2352x1568.
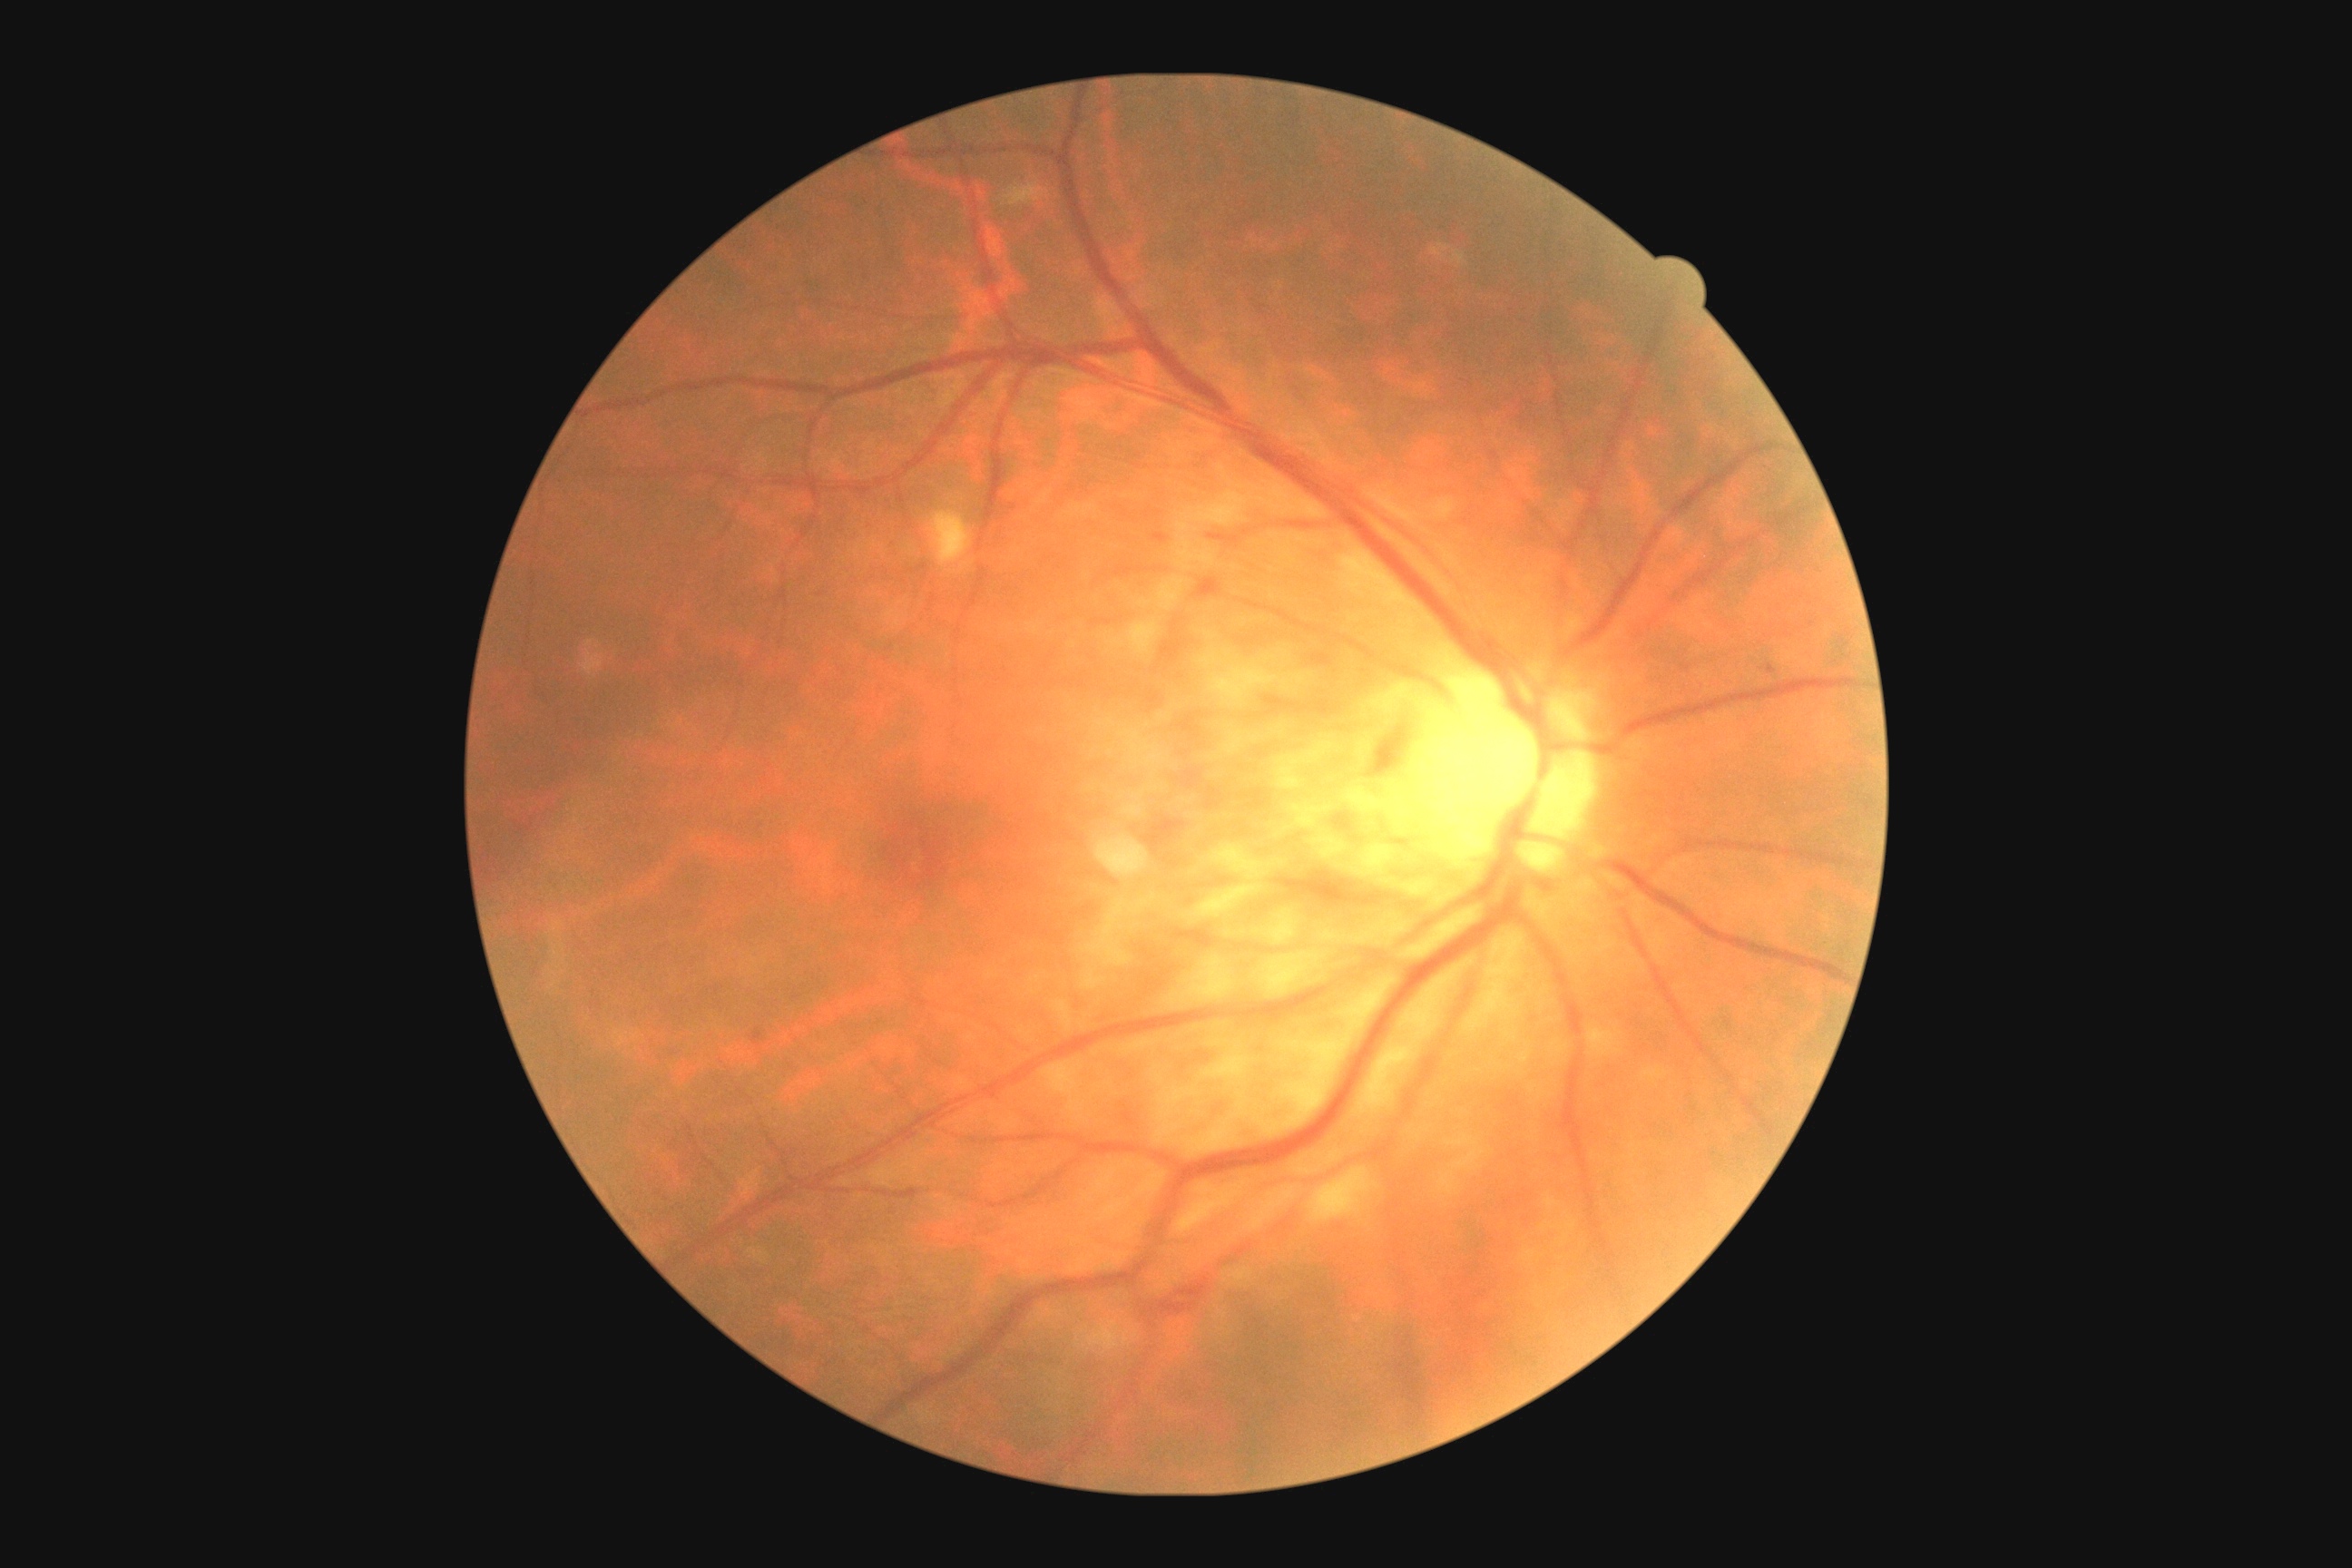
DR: moderate NPDR (grade 2) — more than just microaneurysms but less than severe NPDR.